Color fundus photograph centered on the optic disc, image size 571x571:
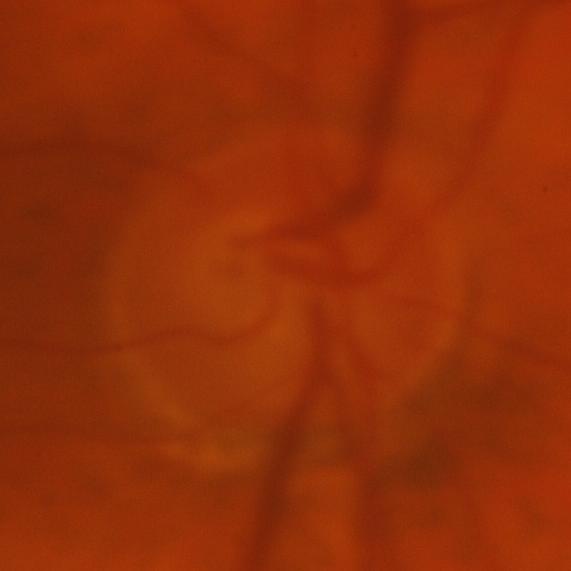

Glaucomatous changes are present. There is evidence of glaucoma.